Captured without pupil dilation: 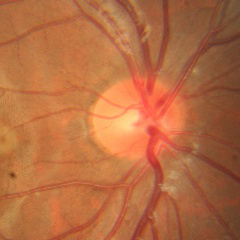 Demonstrates no signs of glaucoma.